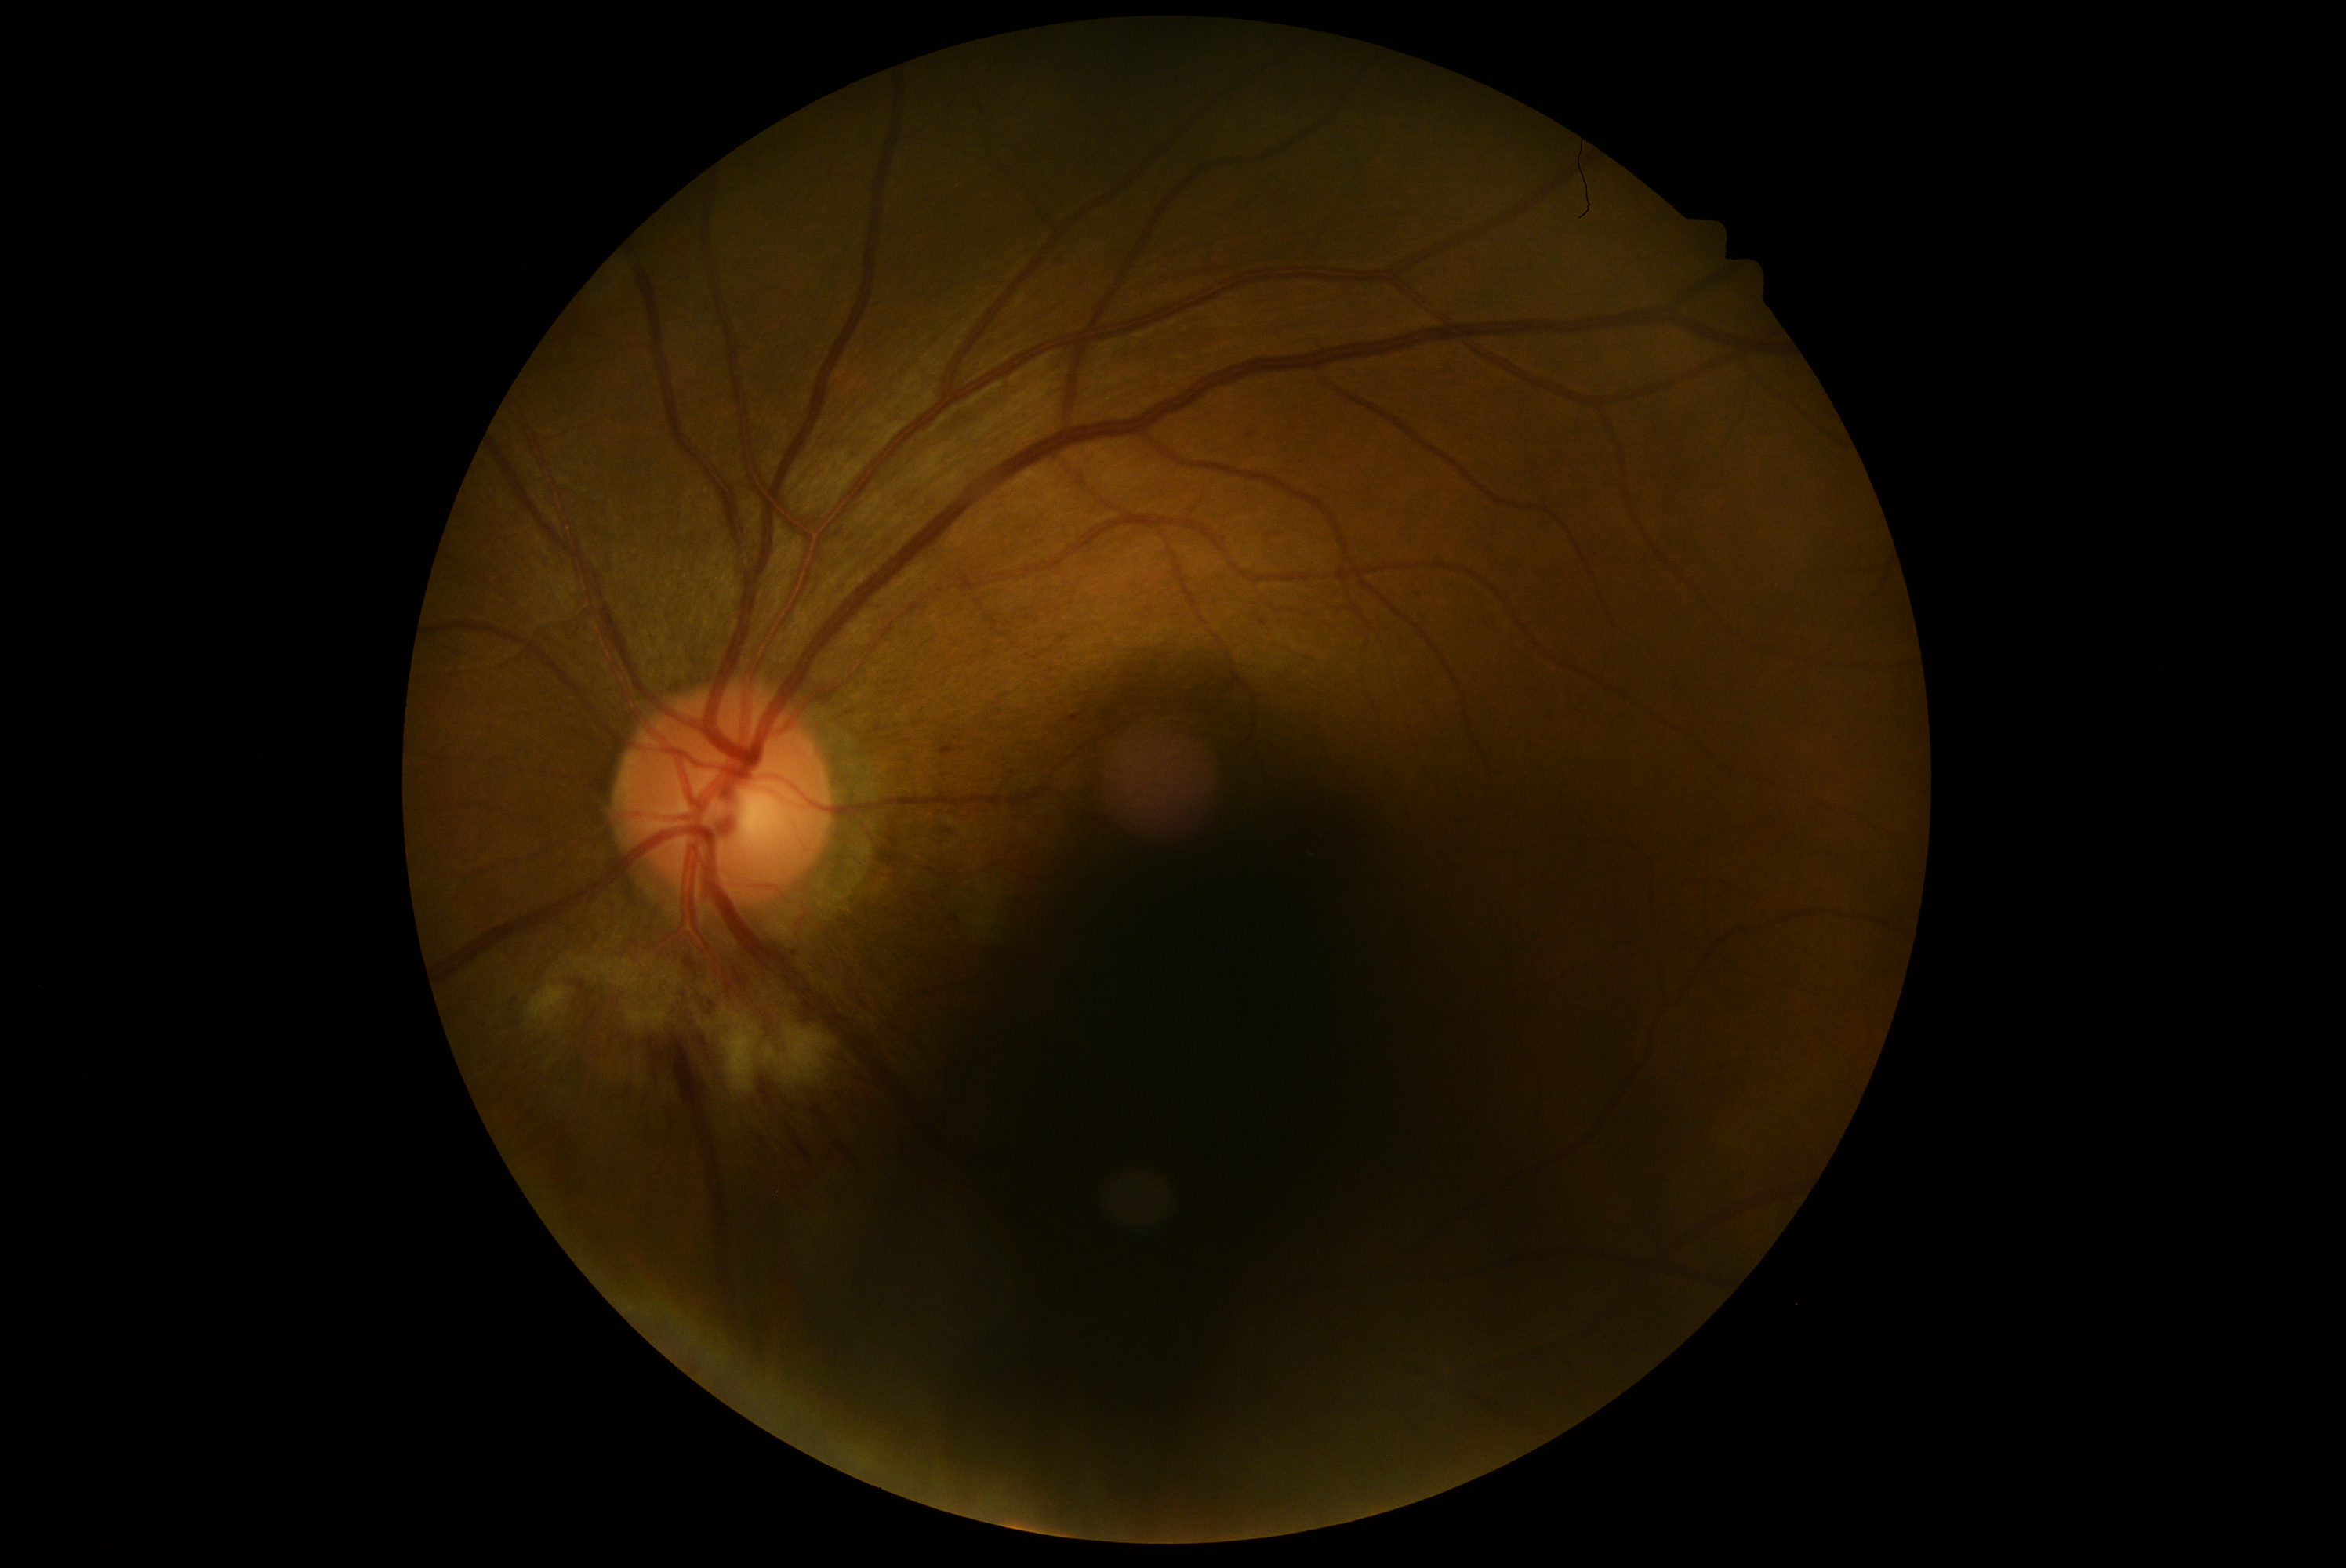
Diabetic retinopathy (DR) is 2/4. The retinopathy is classified as non-proliferative diabetic retinopathy.